848 x 848 pixels, 45-degree field of view — 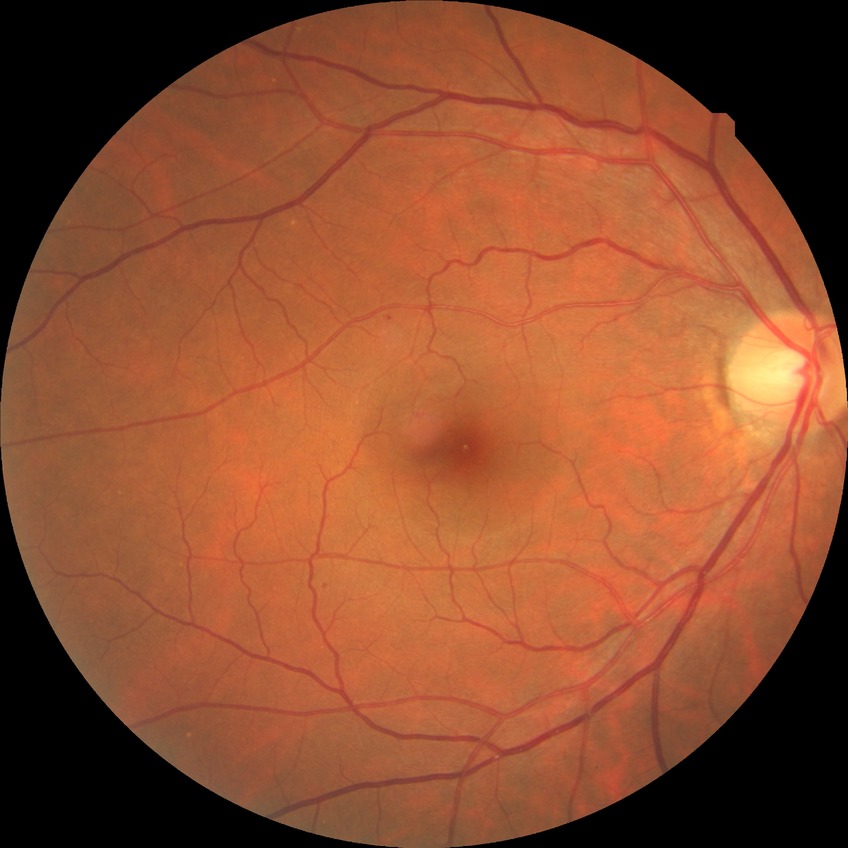
Assessment:
* diabetic retinopathy (DR) — NDR (no diabetic retinopathy)